Image size 2346x1568; 45-degree field of view:
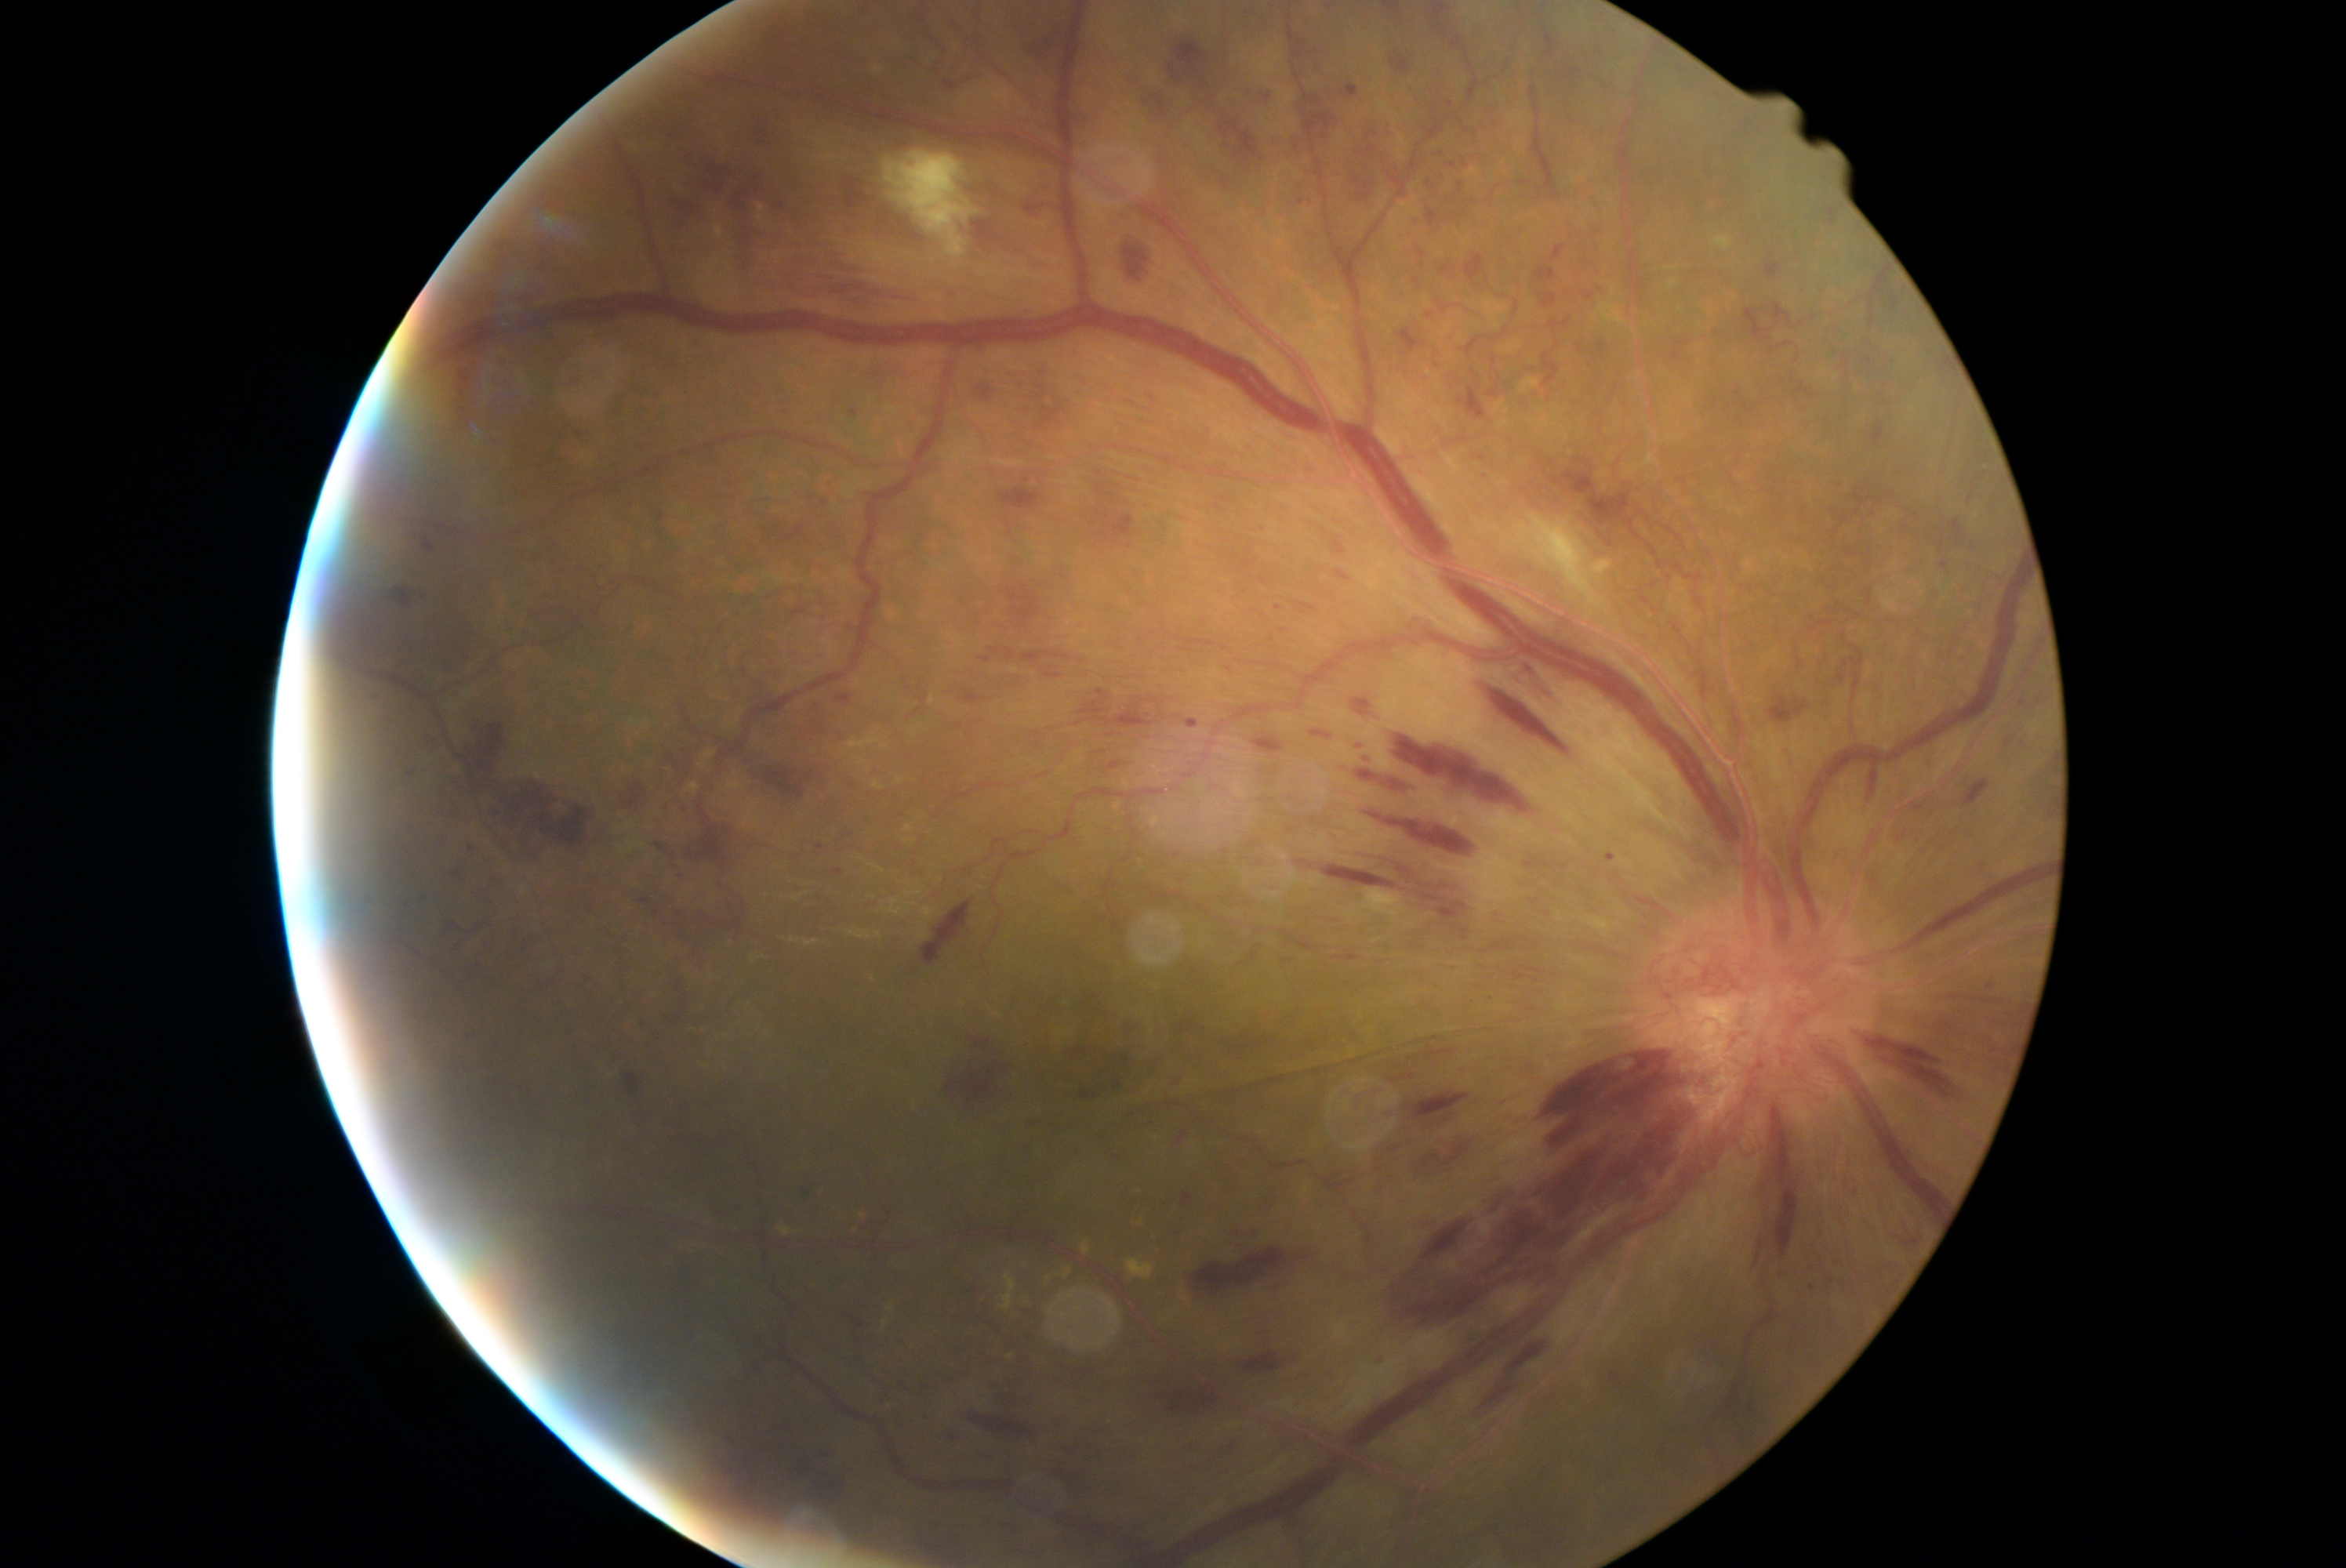 Diabetic retinopathy (DR): 4. Hemorrhages (HEs) (partial list) at [left=1160, top=1390, right=1221, bottom=1412] | [left=1431, top=16, right=1456, bottom=40] | [left=383, top=586, right=427, bottom=609] | [left=832, top=869, right=844, bottom=876] | [left=1828, top=209, right=1837, bottom=225] | [left=1142, top=96, right=1160, bottom=117] | [left=492, top=775, right=592, bottom=862] | [left=818, top=843, right=824, bottom=851] | [left=1911, top=804, right=1923, bottom=813] | [left=1075, top=1051, right=1133, bottom=1100] | [left=1221, top=667, right=1238, bottom=683] | [left=625, top=1073, right=644, bottom=1095] | [left=1484, top=1385, right=1517, bottom=1409] | [left=459, top=374, right=473, bottom=390] | [left=1064, top=695, right=1200, bottom=728] | [left=1169, top=38, right=1210, bottom=87] | [left=462, top=844, right=476, bottom=857]. Small HEs near x=680 y=914 | x=1901 y=840 | x=1485 y=476.